CFP:
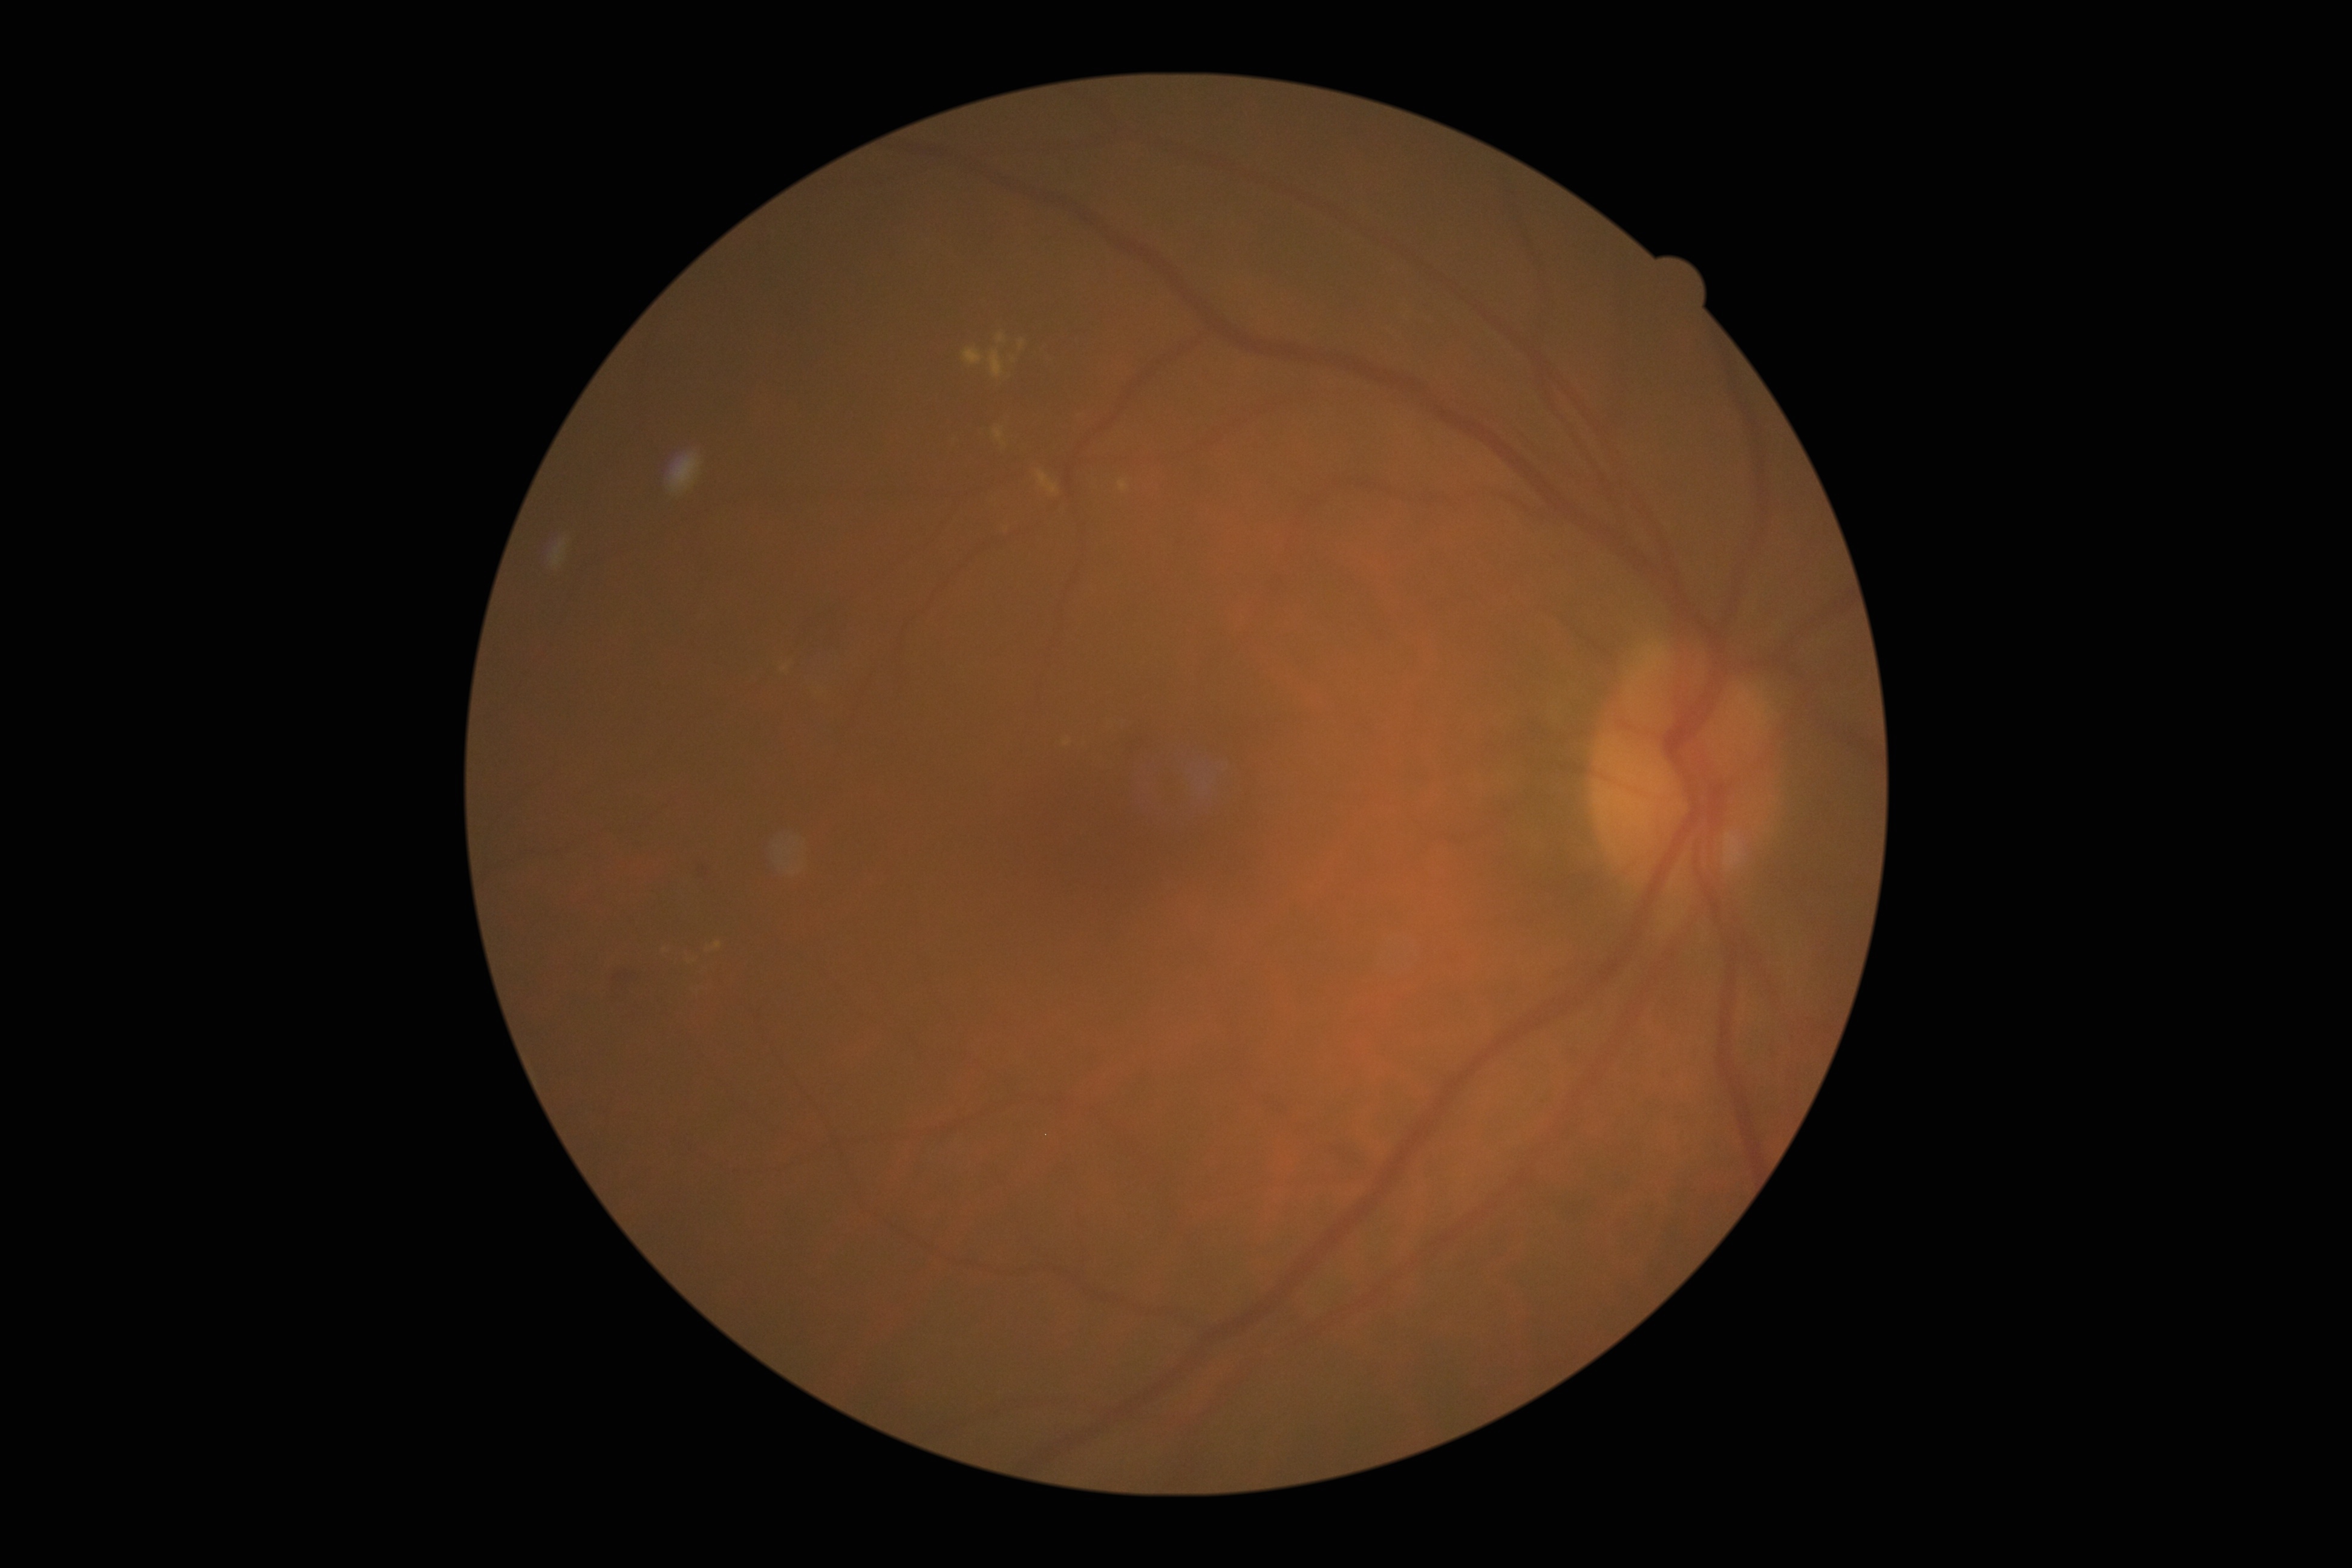 DR: grade 2.